2352 by 1568 pixels.
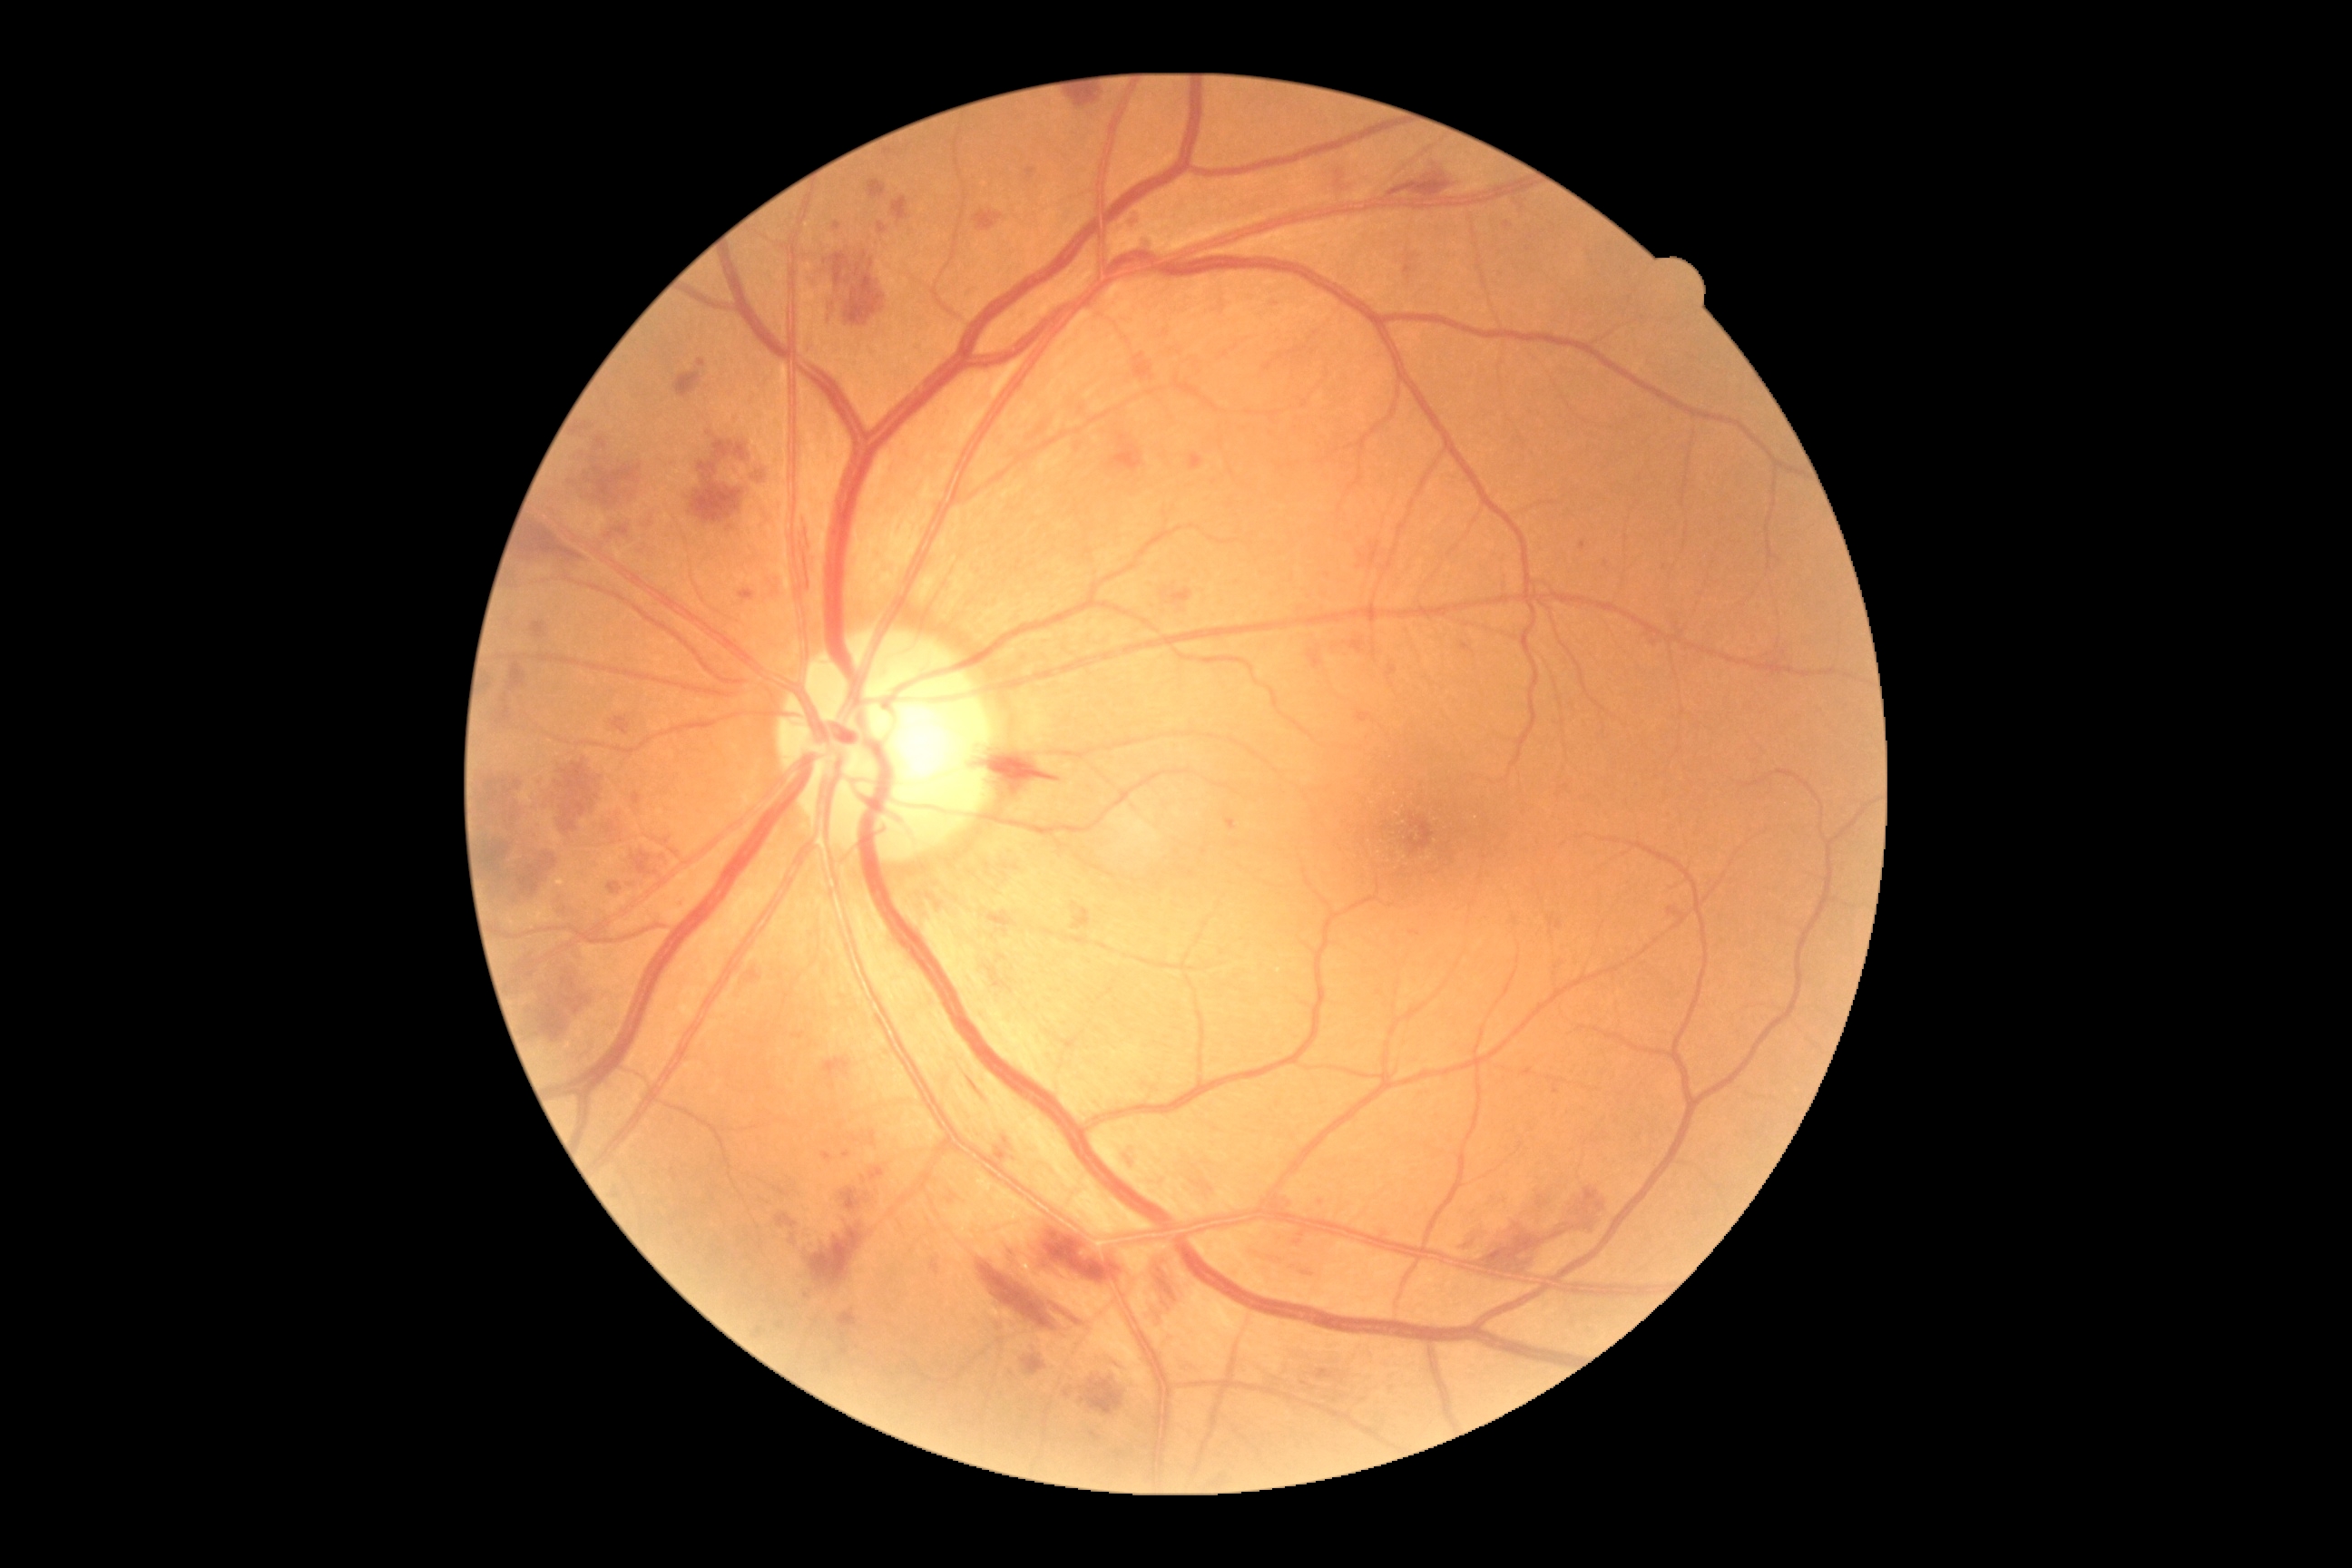

{"partial": true, "dr_grade": 3, "lesions": {"he": [[776, 1215, 798, 1228], [487, 774, 522, 832], [496, 707, 513, 725], [810, 1224, 865, 1286], [841, 1190, 868, 1211], [1358, 542, 1380, 571], [892, 197, 908, 224], [607, 883, 623, 896], [631, 852, 667, 879], [1023, 1357, 1046, 1377], [1484, 1224, 1544, 1273], [714, 440, 749, 462], [977, 1260, 1055, 1331], [803, 544, 810, 591], [1072, 92, 1099, 106]]}}